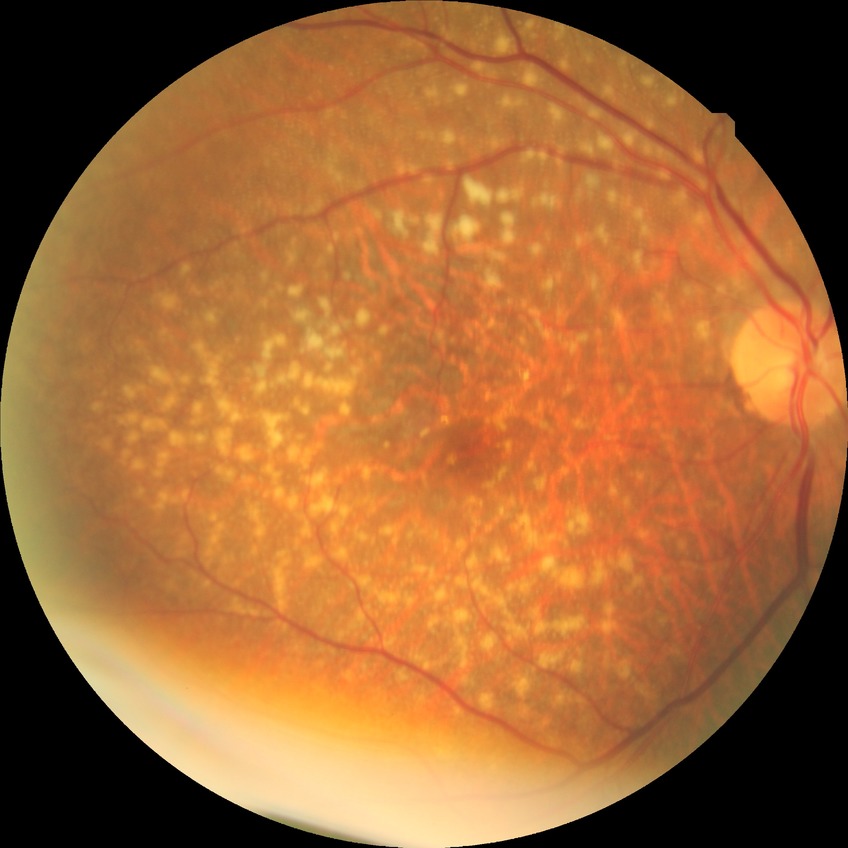

Diabetic retinopathy stage is no diabetic retinopathy.